848 by 848 pixels, DR severity per modified Davis staging, 45° field of view, nonmydriatic, posterior pole color fundus photograph, NIDEK AFC-230
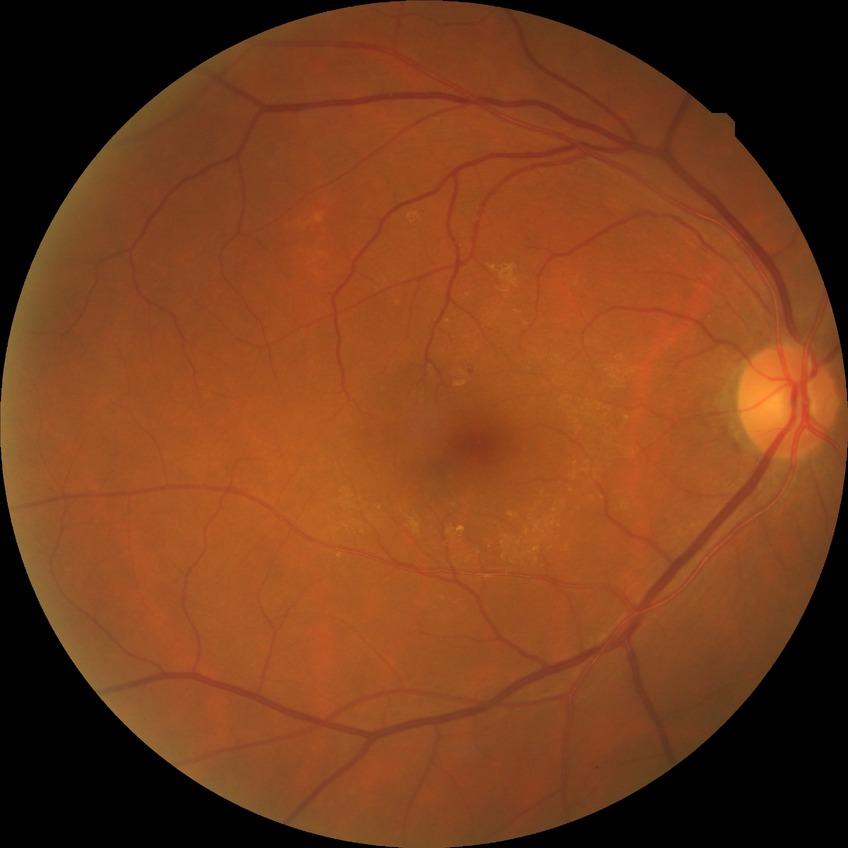

modified Davis classification = no diabetic retinopathy.